CFP:
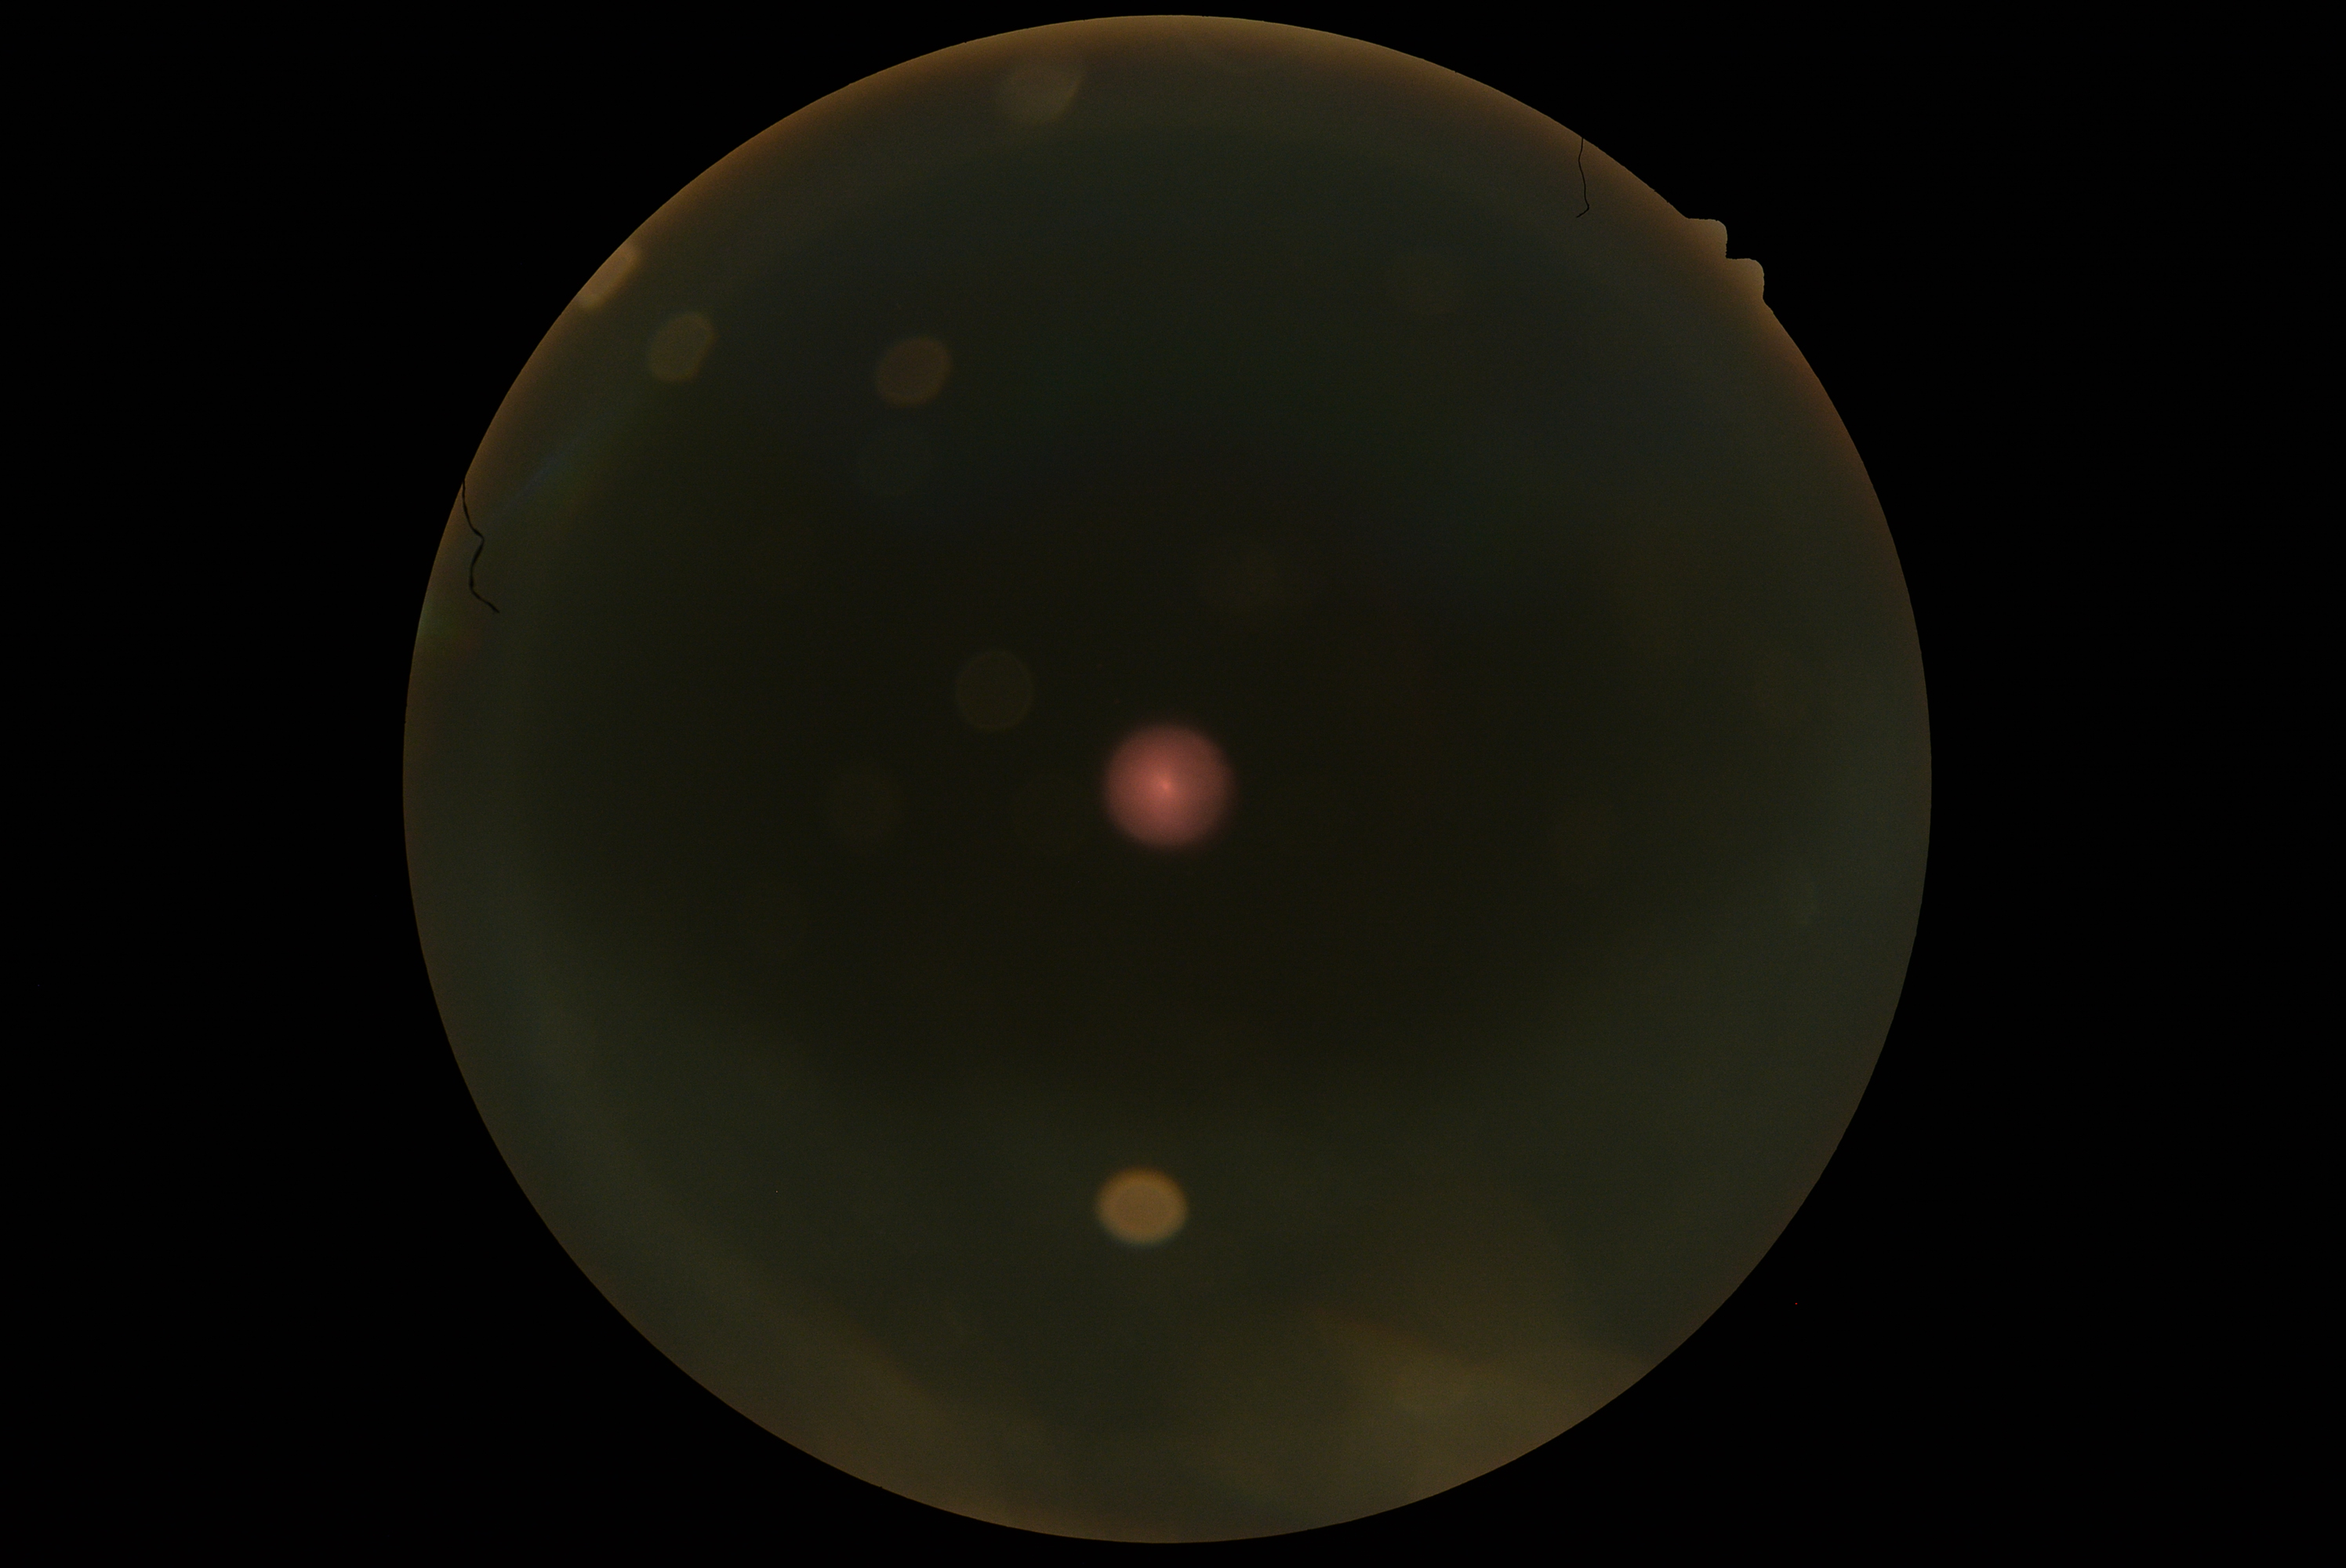

Image quality is insufficient for diabetic retinopathy assessment. Diabetic retinopathy is ungradable due to poor image quality.